848 by 848 pixels · CFP · modified Davis classification:
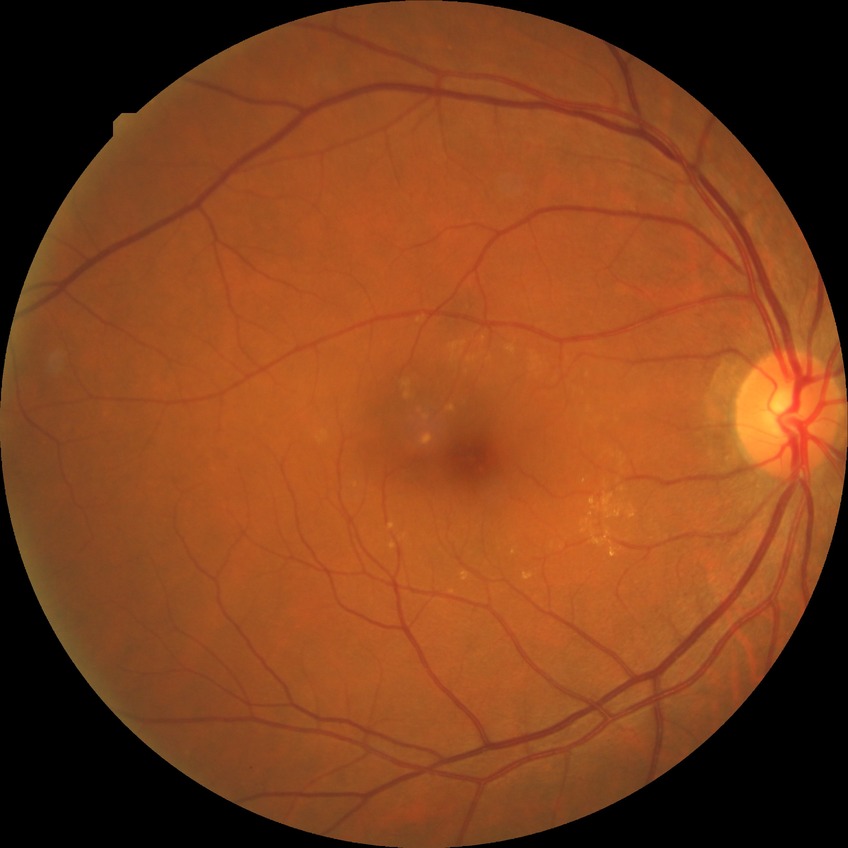
Diabetic retinopathy (DR) is NDR (no diabetic retinopathy).